Infant wide-field fundus photograph · camera: Clarity RetCam 3 (130° FOV):
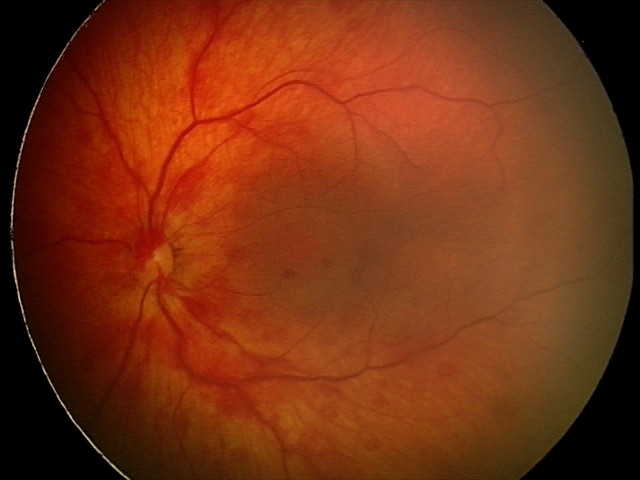 Q: What was the screening finding?
A: retinal hemorrhages